Captured with the Natus RetCam Envision (130° field of view); pediatric retinal photograph (wide-field): 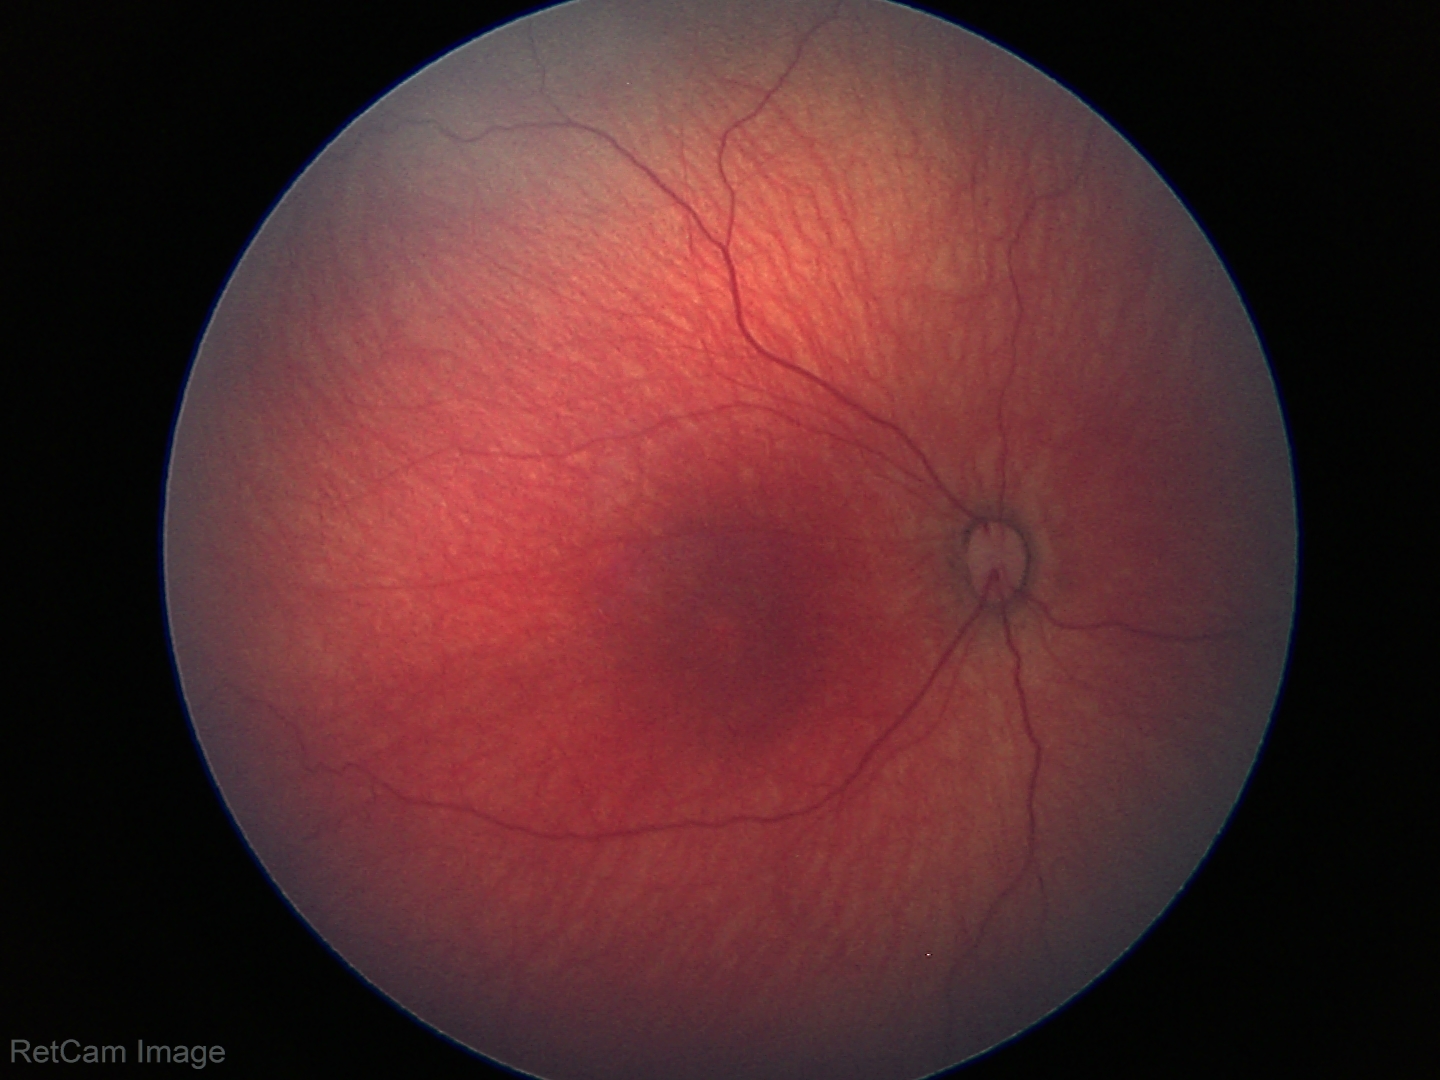

Normal screening examination.